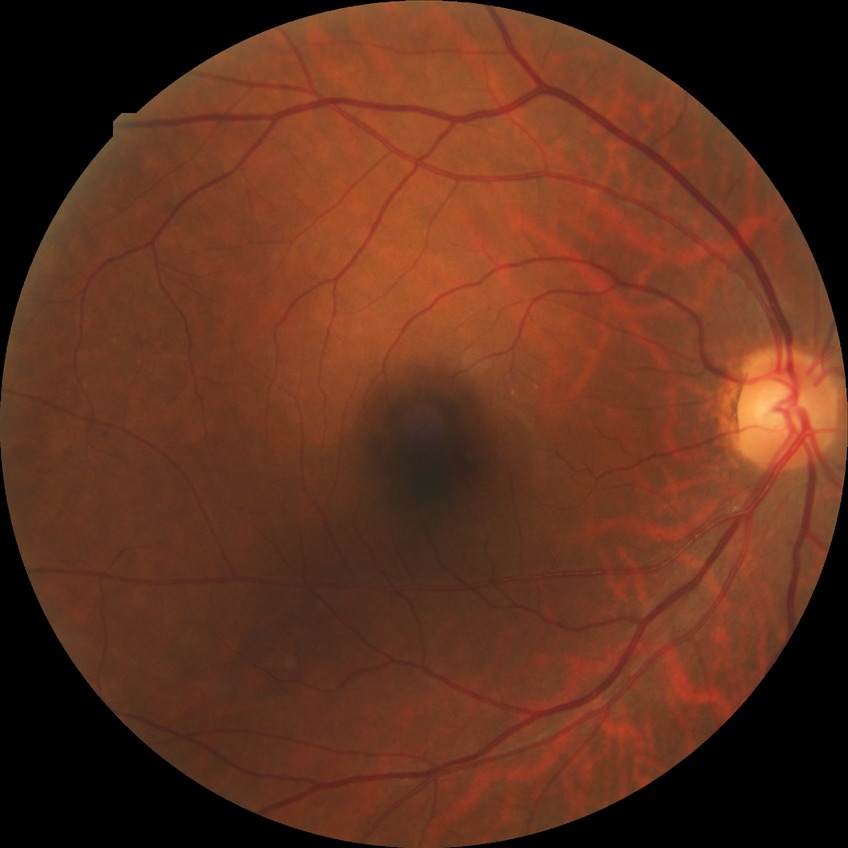 DR severity: NDR.
No signs of diabetic retinopathy.